Remidio FOP fundus camera; color fundus photograph; 1659x2212 — 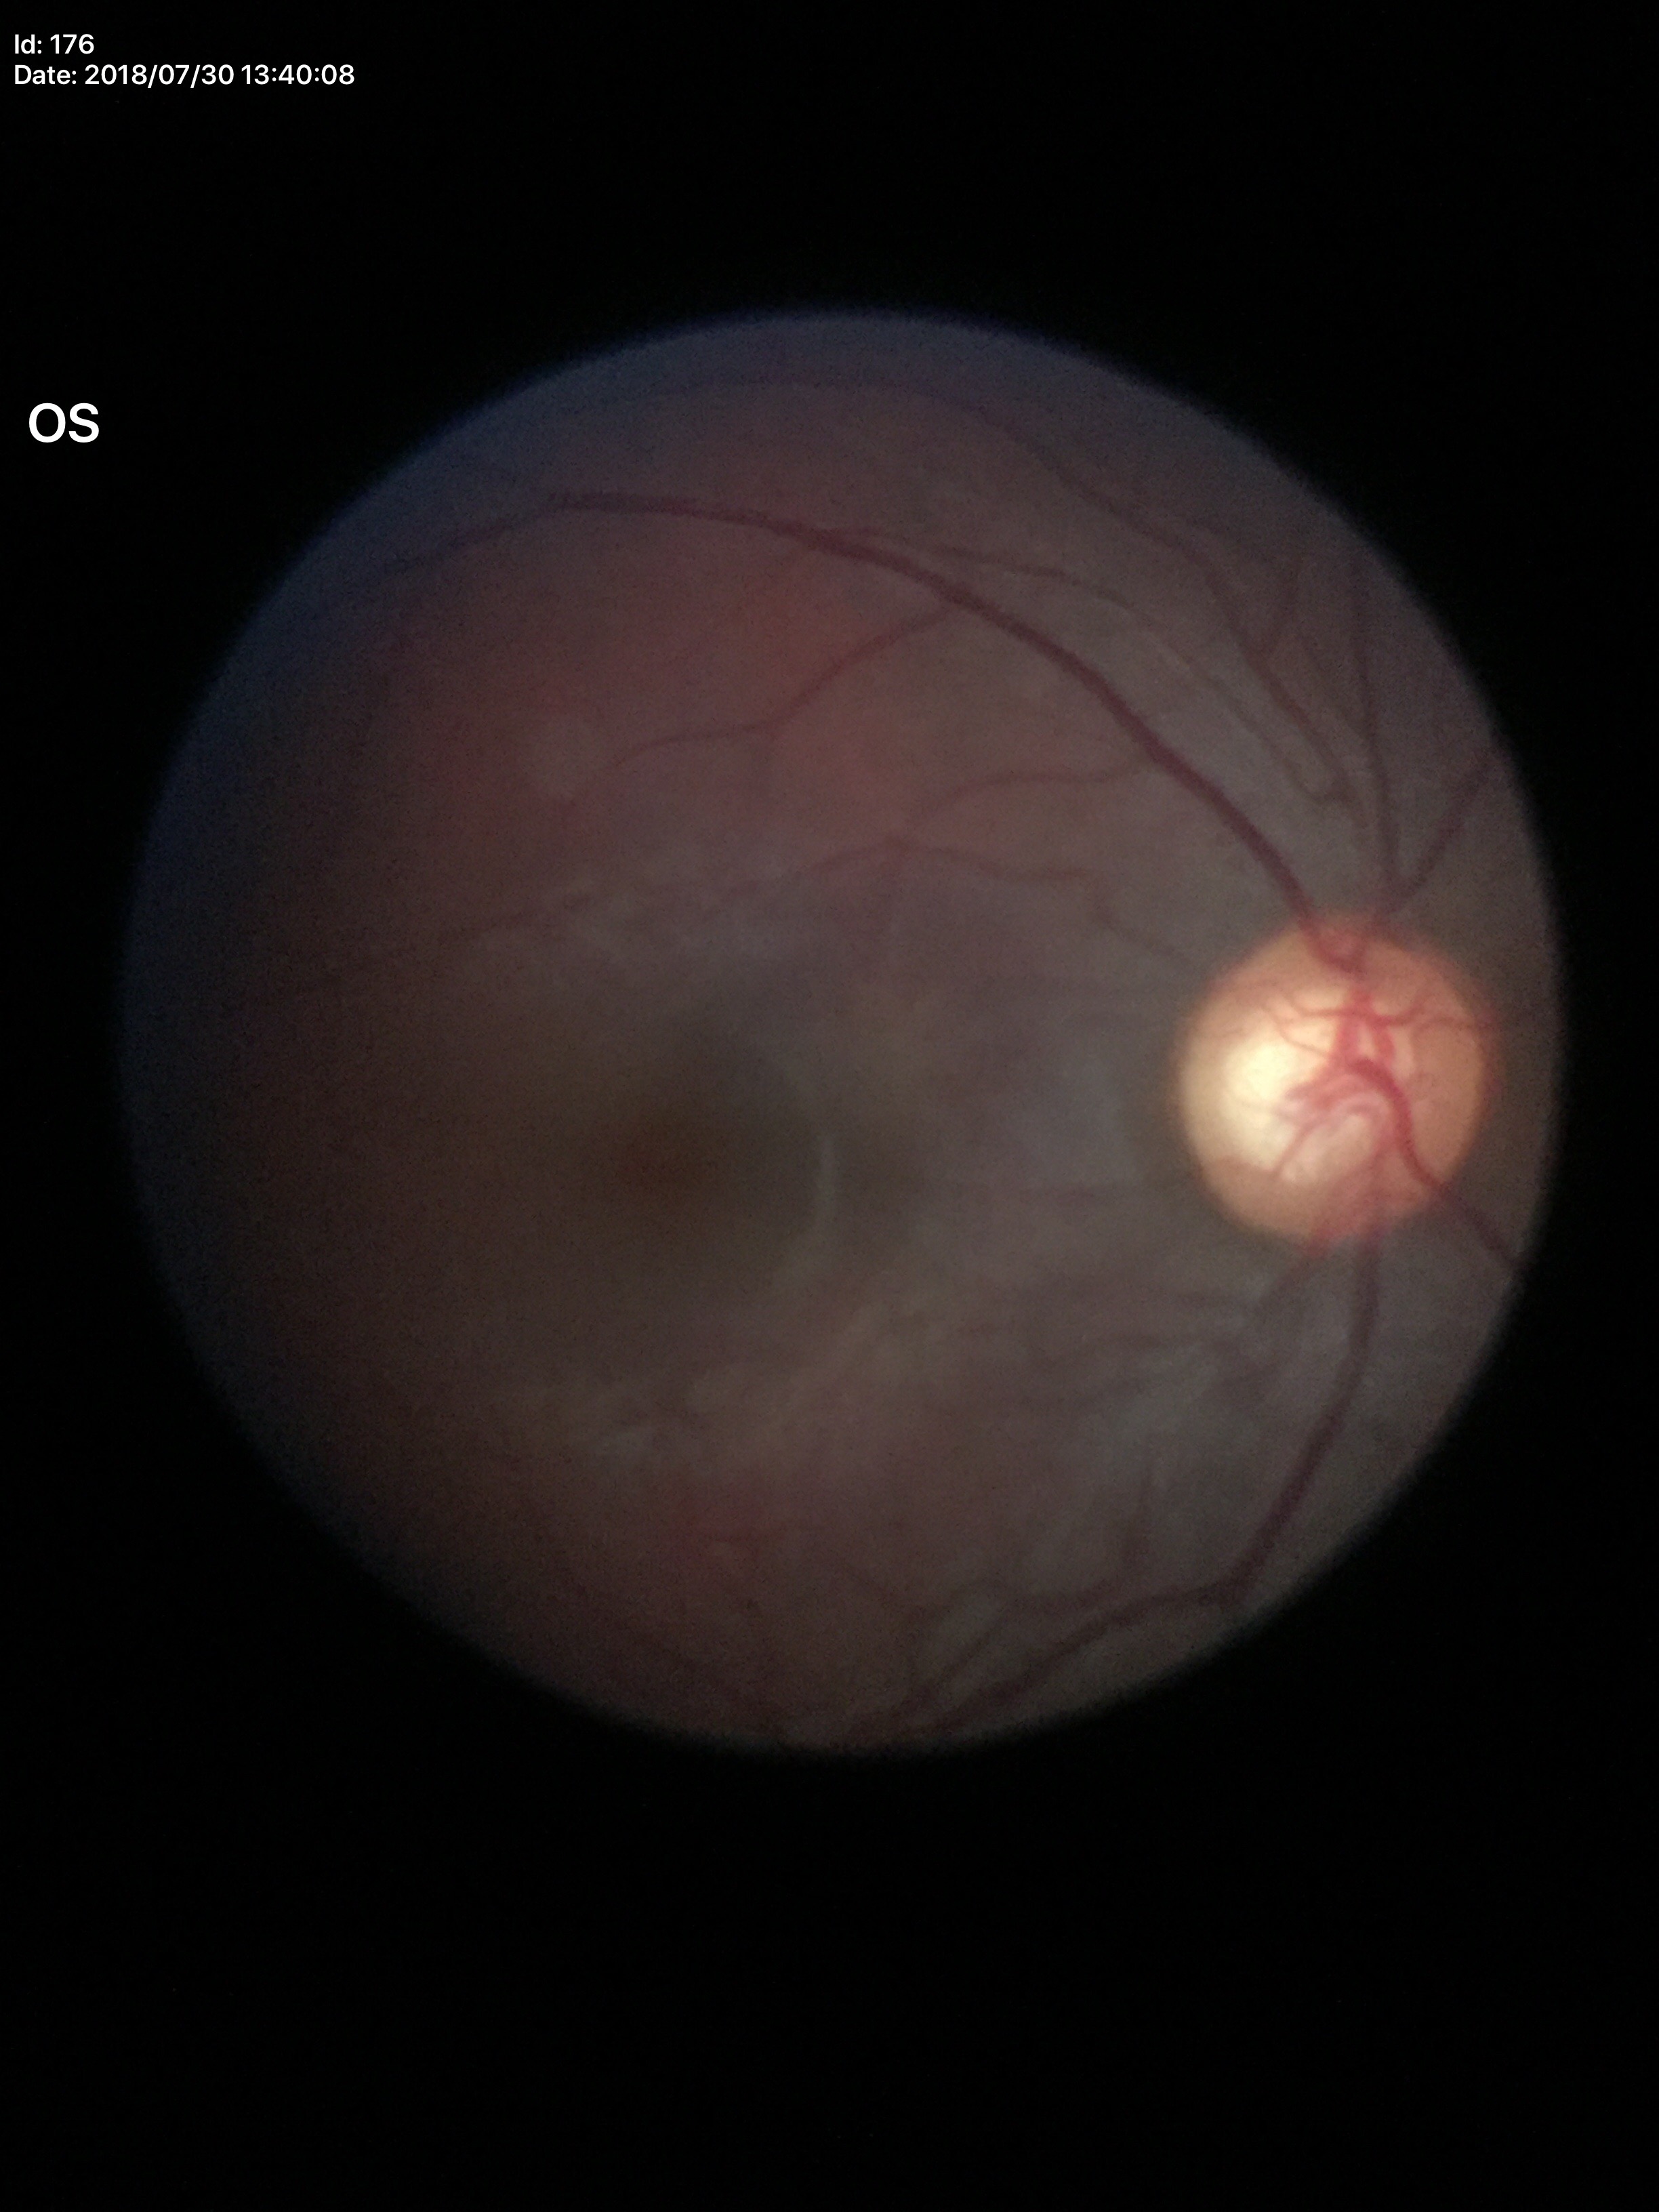
Glaucoma screening impression=suspicious
VCDR=0.64
HCDR=0.66